Wide-field fundus image from infant ROP screening — 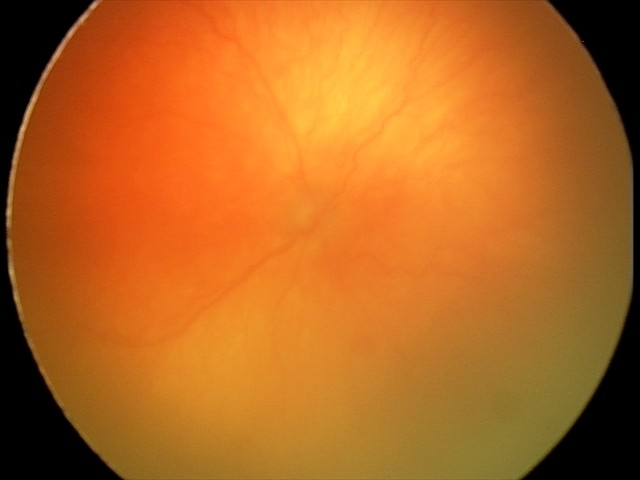 Plus disease was diagnosed. Examination diagnosed as aggressive retinopathy of prematurity.